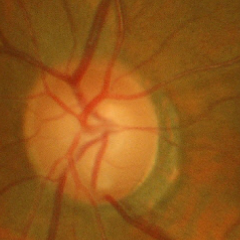 Glaucoma is present.
Early glaucoma.